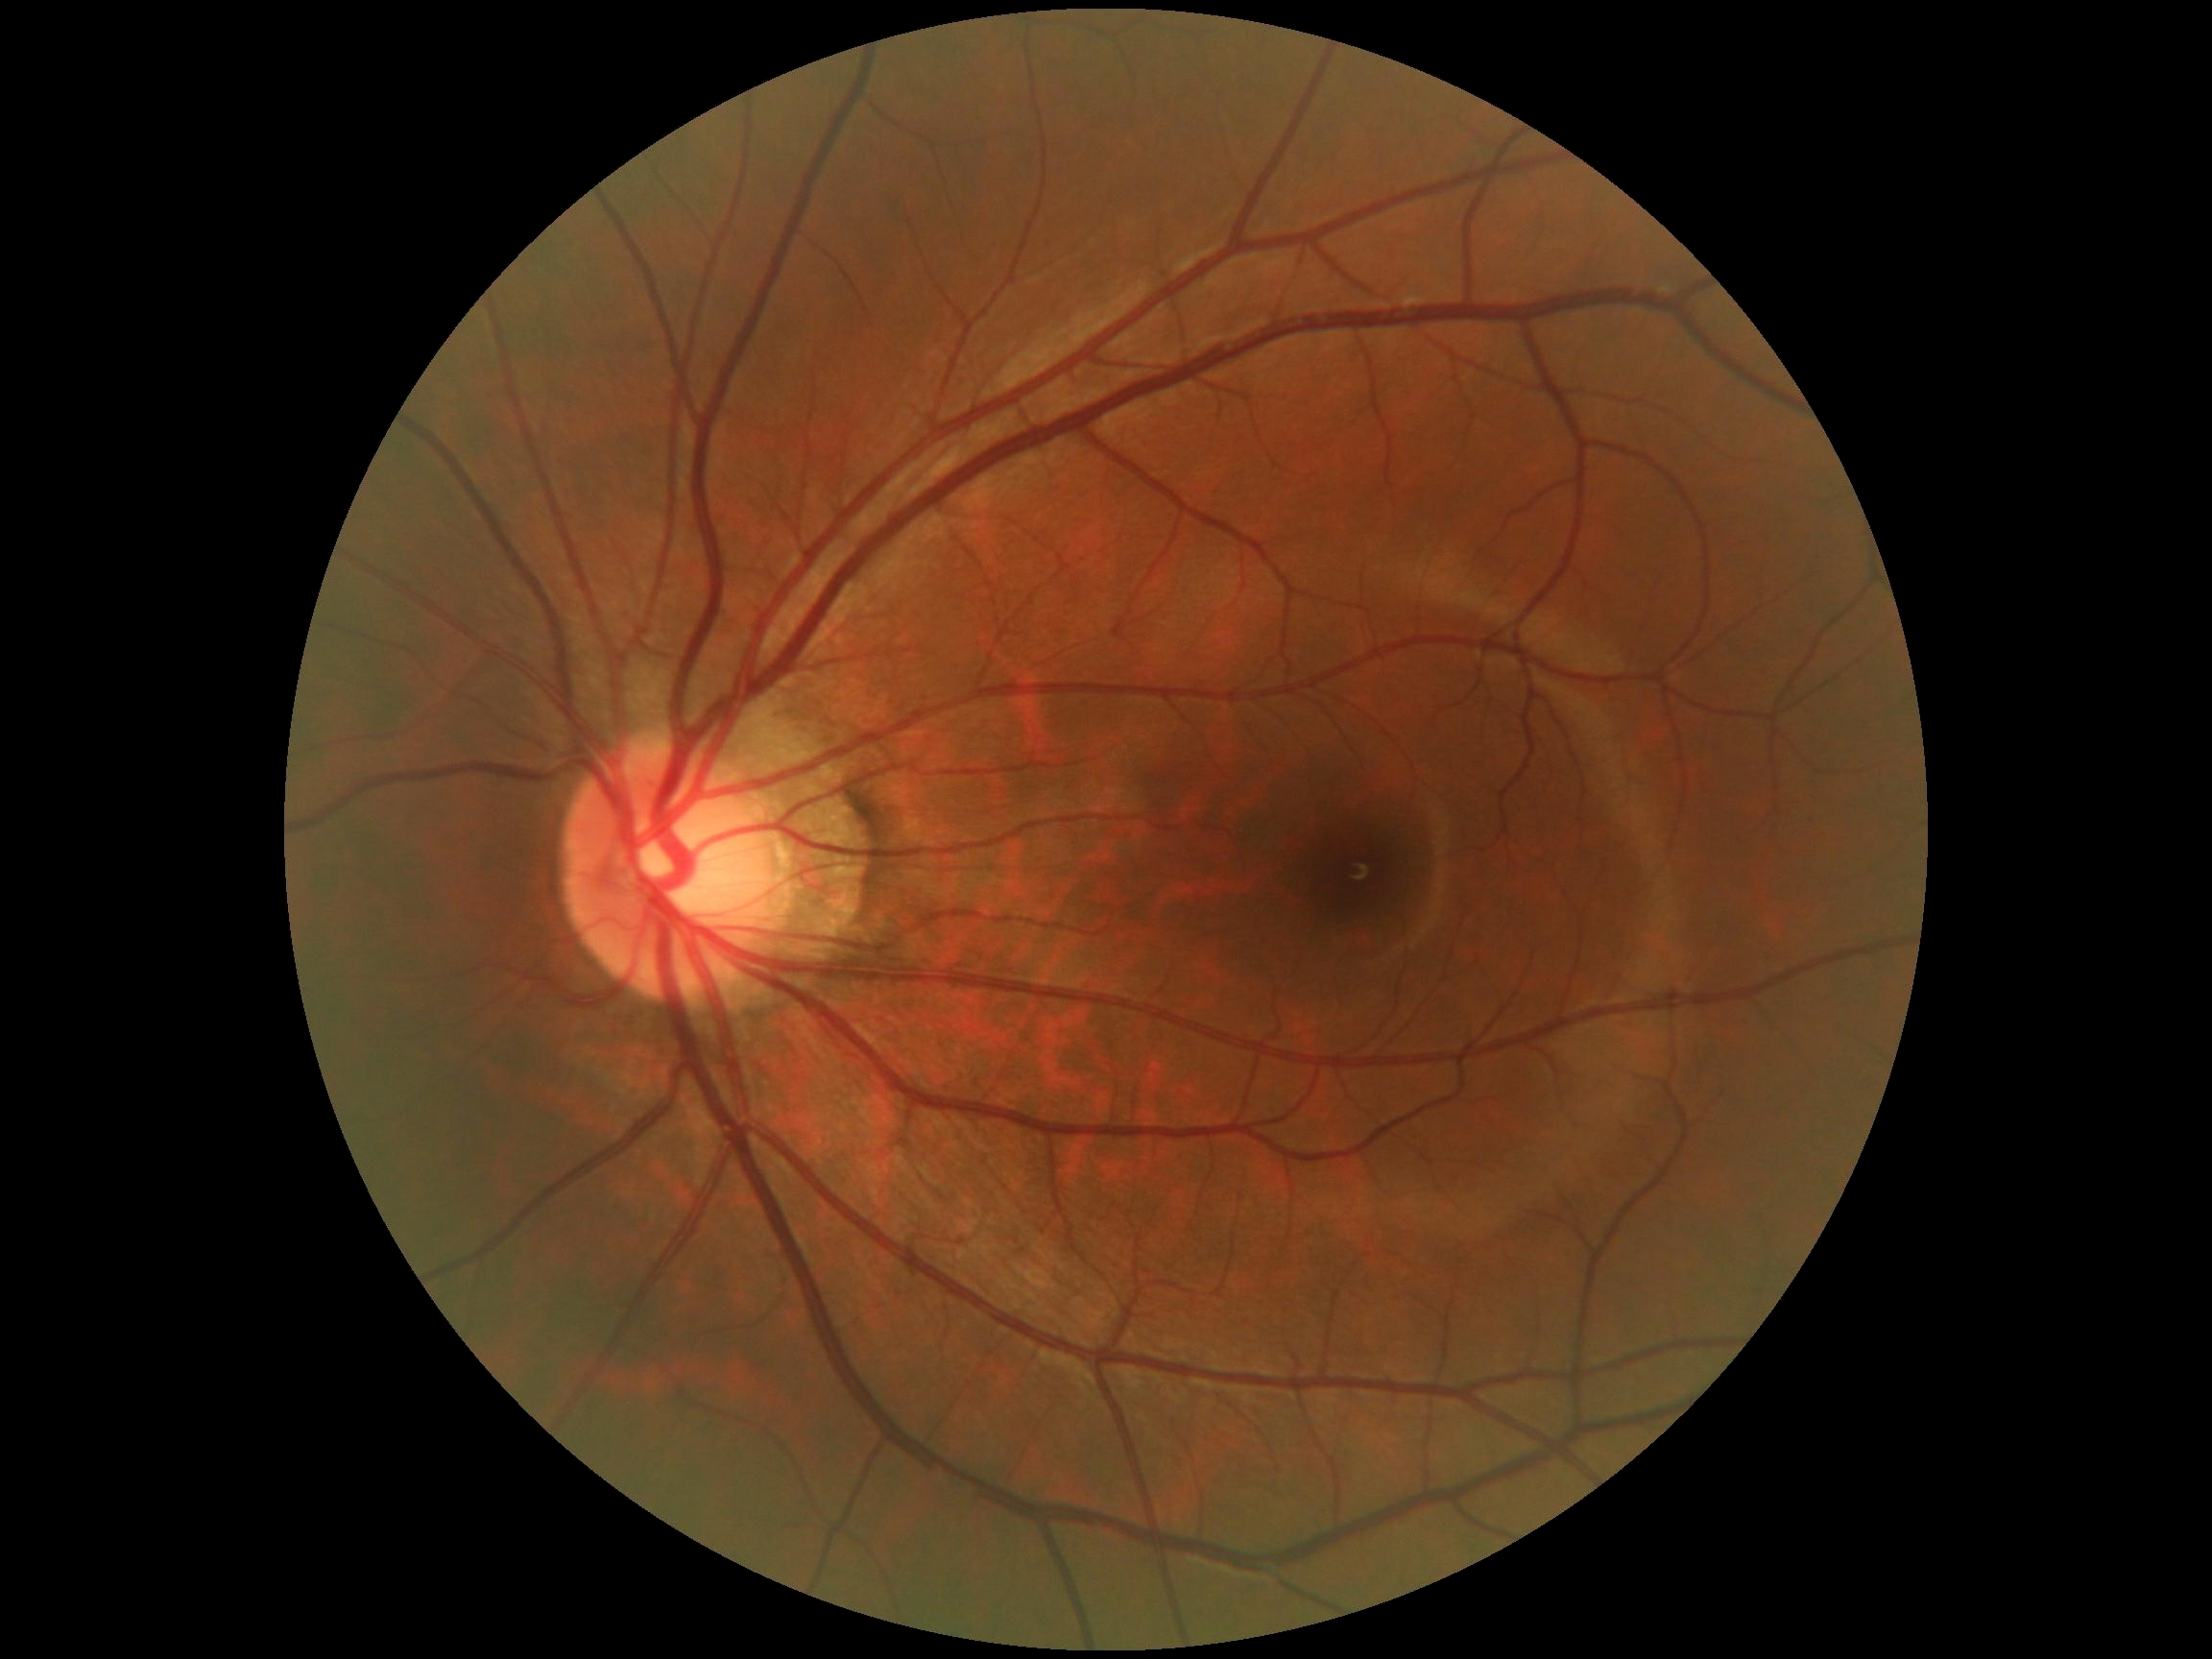 Diabetic retinopathy (DR) is 0/4. No apparent diabetic retinopathy.